Color fundus image.
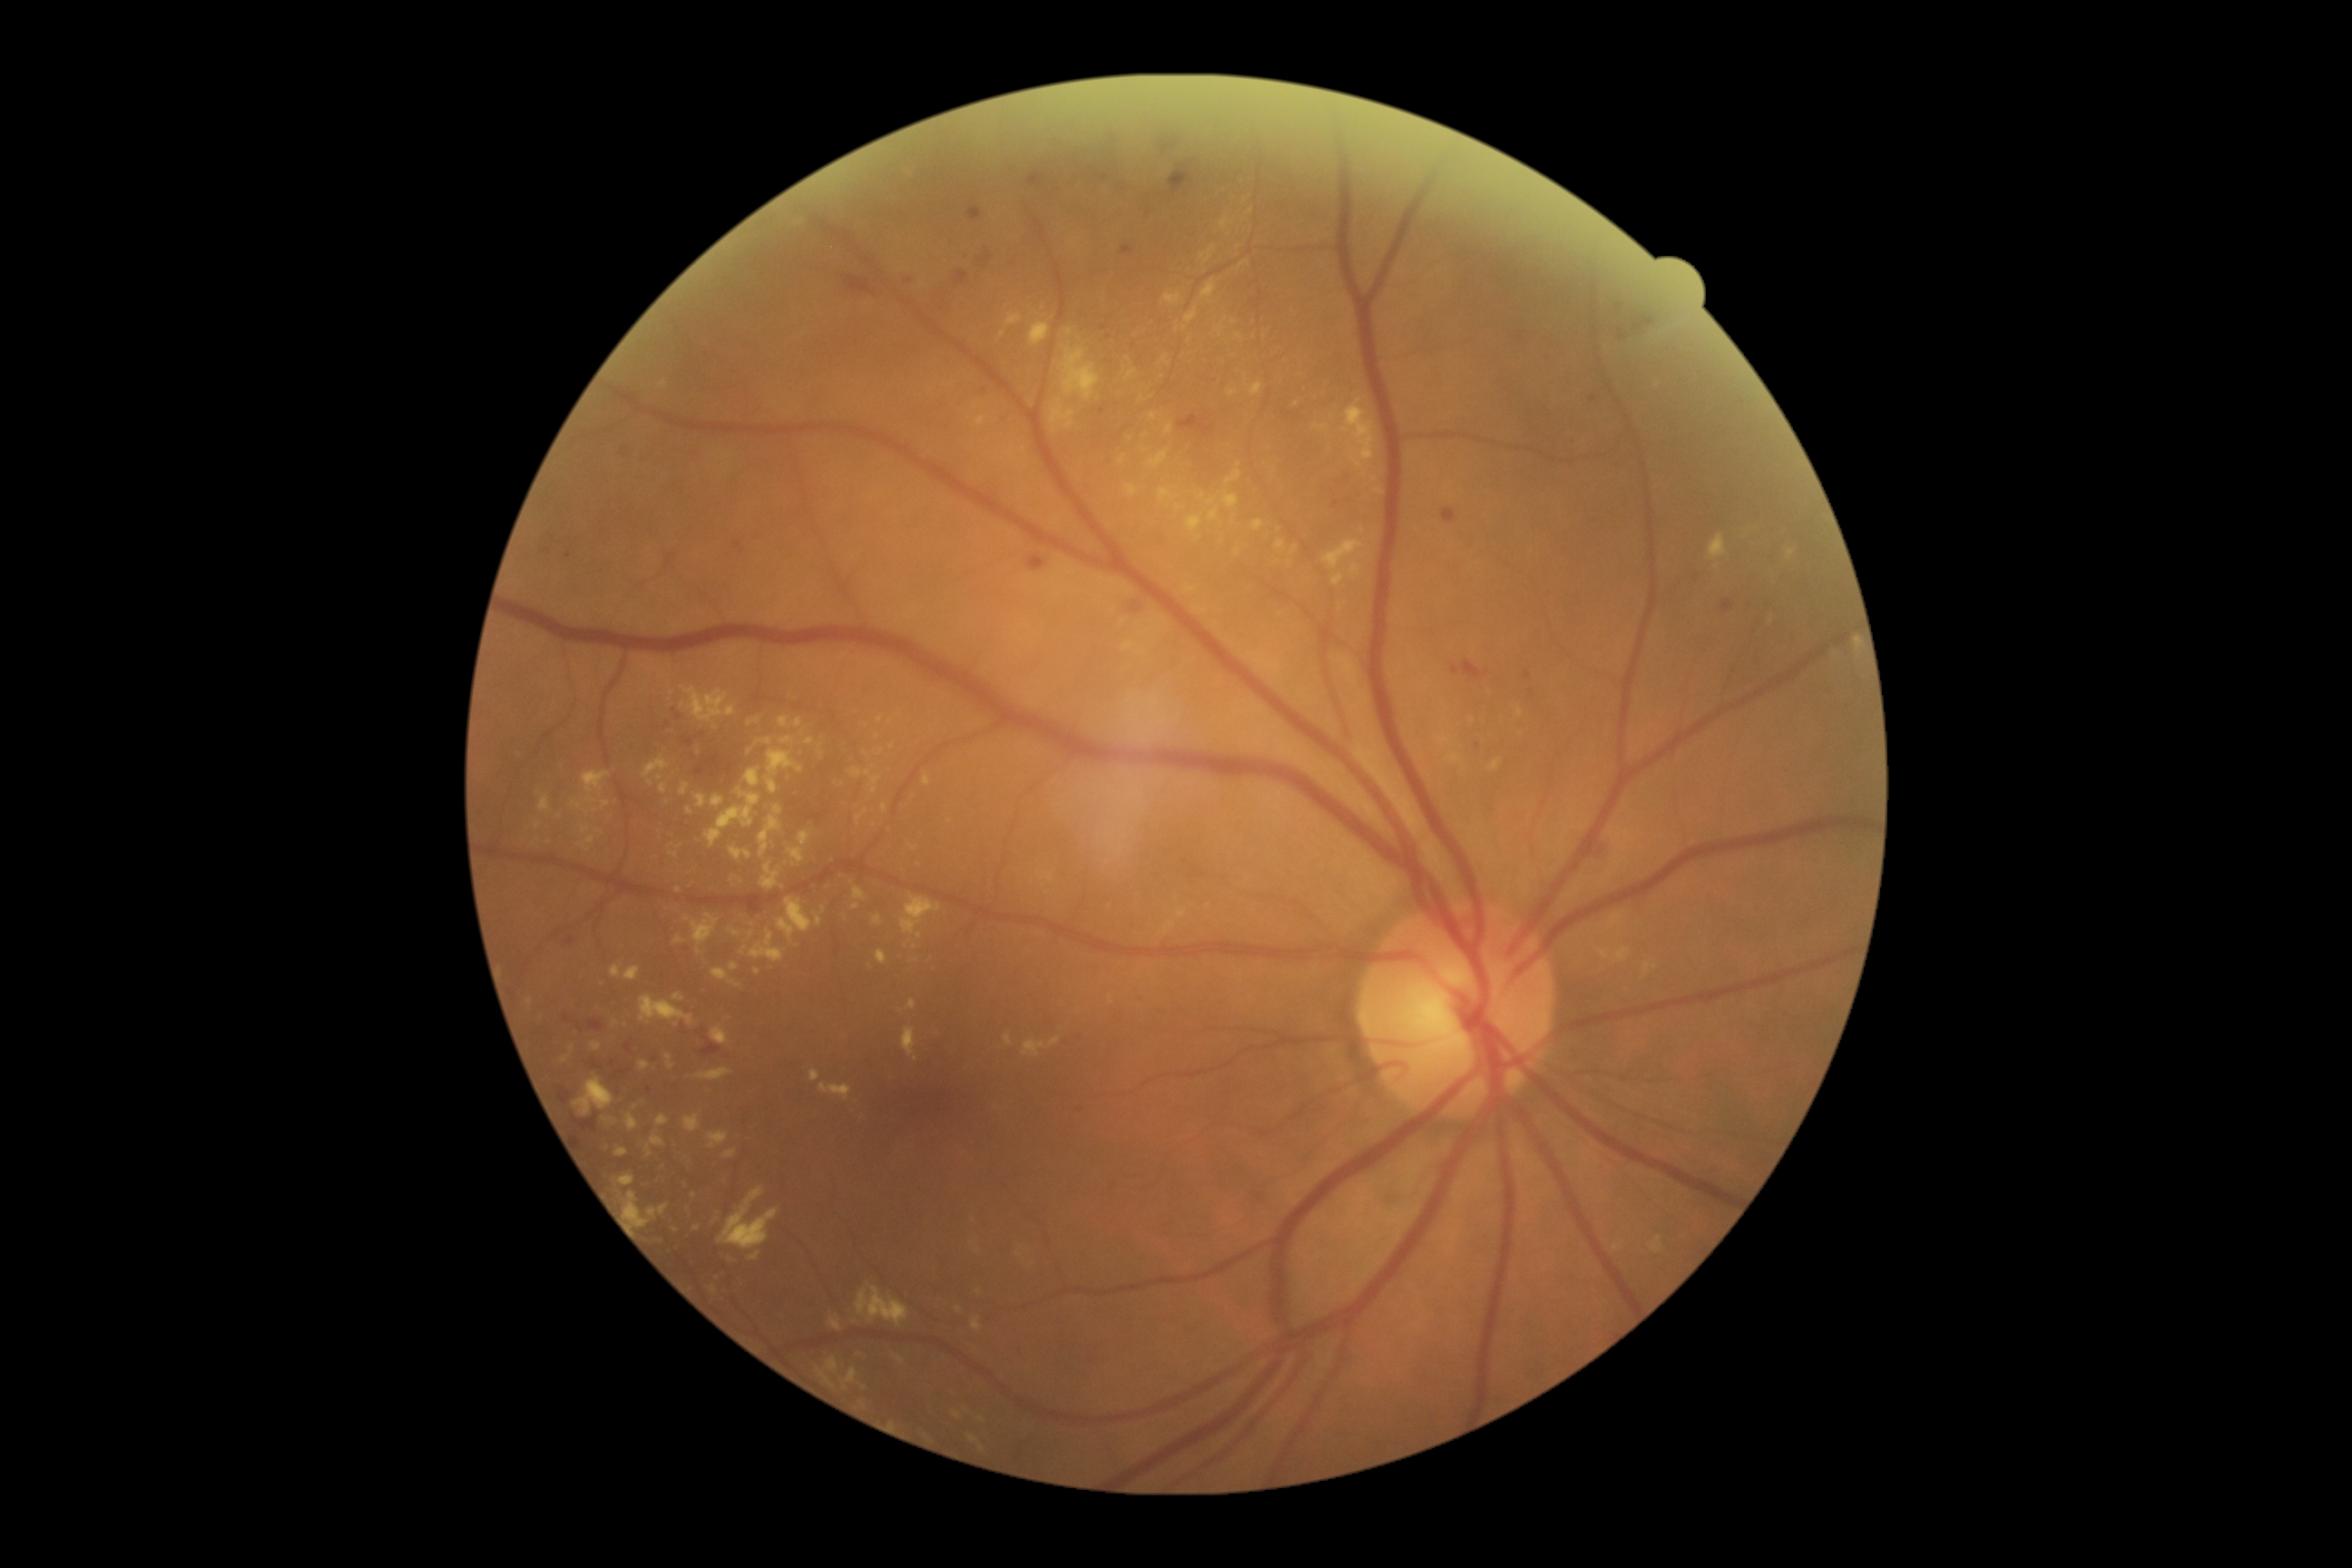

DR stage is moderate non-proliferative diabetic retinopathy (grade 2); non-proliferative diabetic retinopathy
A subset of detected lesions:
EXs (more not shown): region(656, 1115, 671, 1126) | region(796, 718, 803, 729) | region(1162, 357, 1170, 362) | region(1126, 485, 1139, 496) | region(1215, 326, 1224, 337) | region(694, 794, 707, 808) | region(1224, 493, 1239, 509) | region(643, 758, 671, 778) | region(649, 1204, 671, 1219) | region(901, 896, 941, 936) | region(1208, 500, 1217, 505) | region(1004, 1034, 1014, 1046) | region(585, 798, 596, 803)
Small EXs approximately at Point(675, 1230) | Point(1024, 449) | Point(596, 810) | Point(1239, 337) | Point(892, 747)